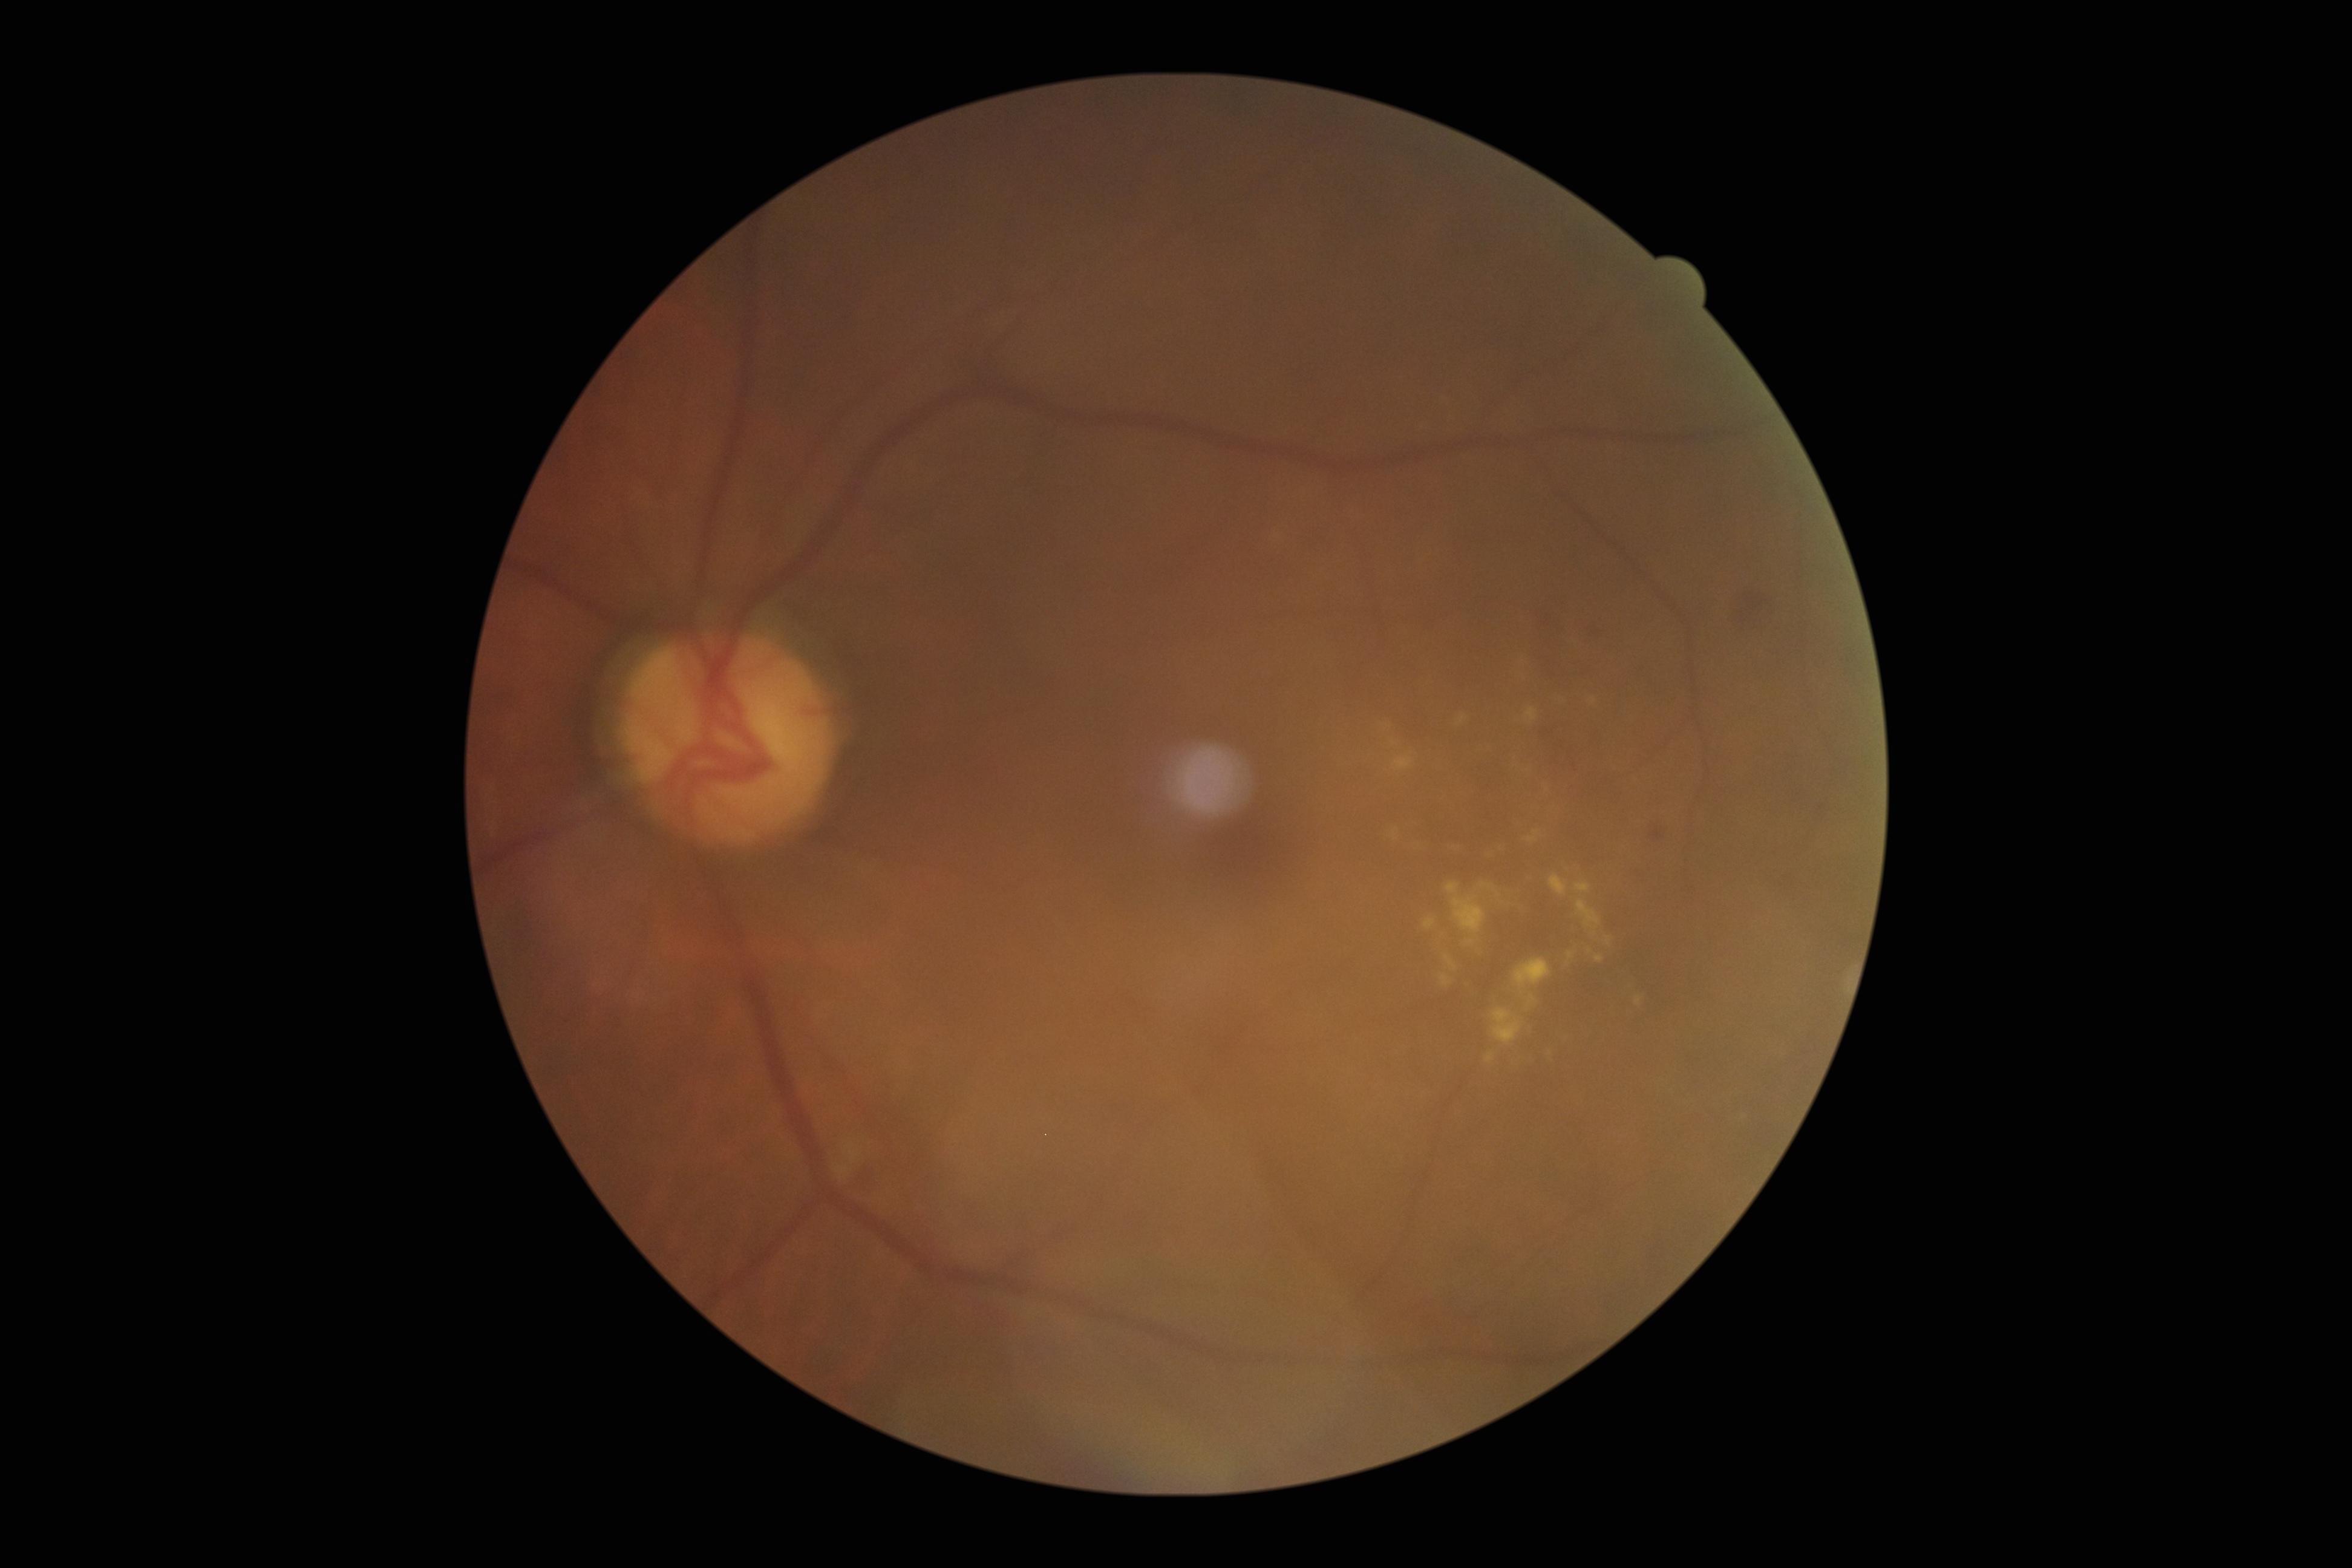

Retinopathy is moderate non-proliferative diabetic retinopathy (grade 2).